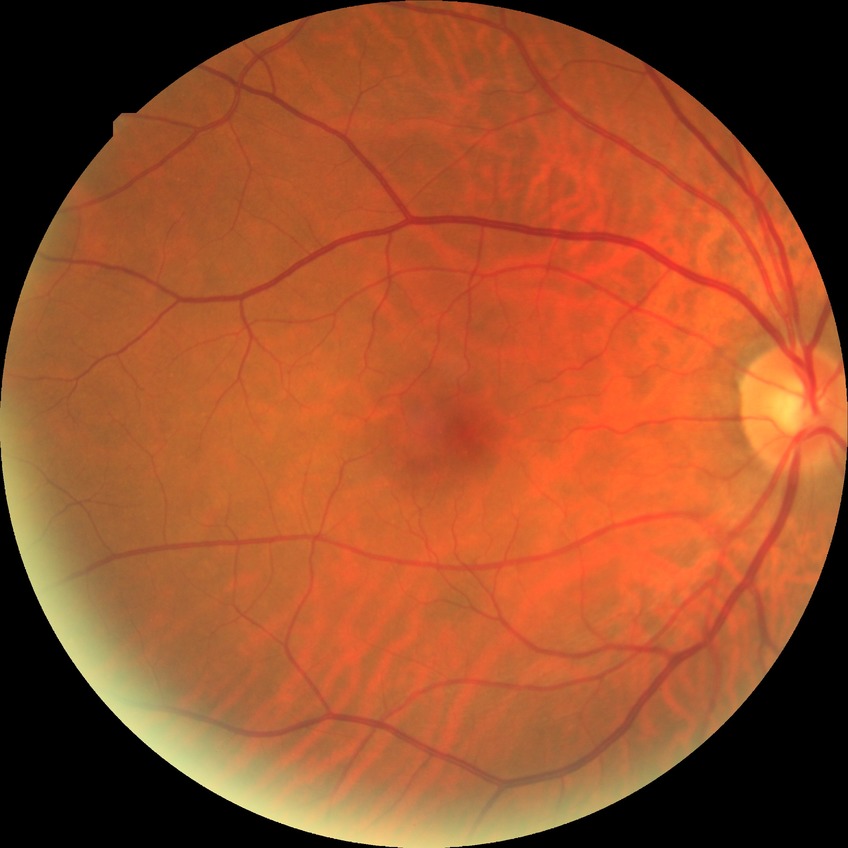
  davis_grade: no diabetic retinopathy